848 x 848 pixels; FOV: 45 degrees; no pharmacologic dilation; fundus photo.
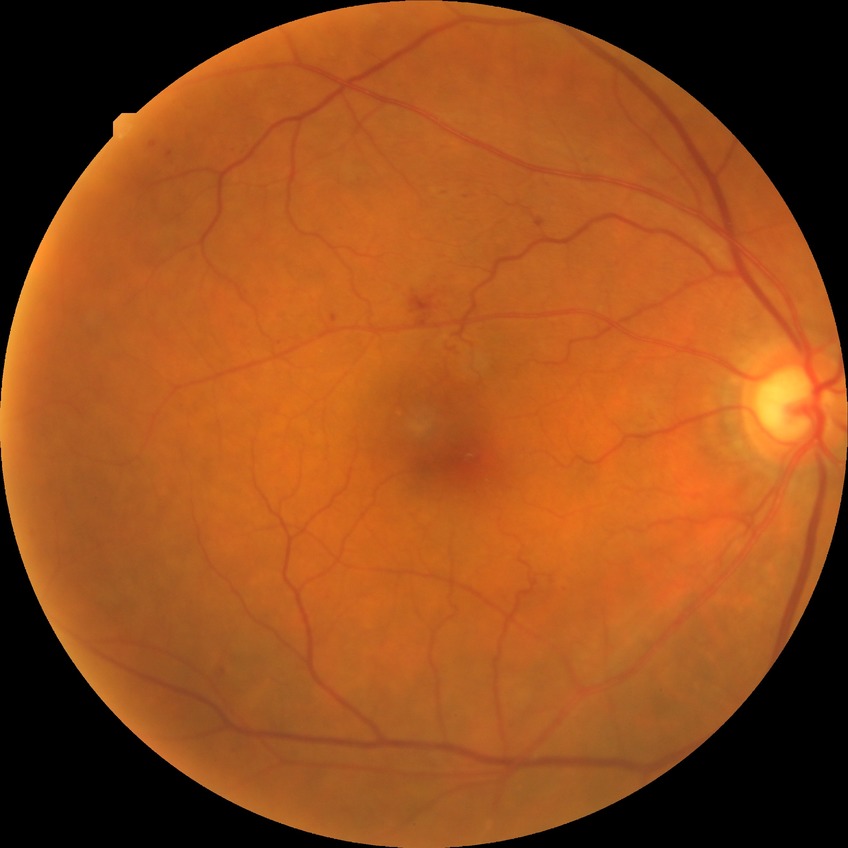
DR grade: SDR.